Modified Davis grading — 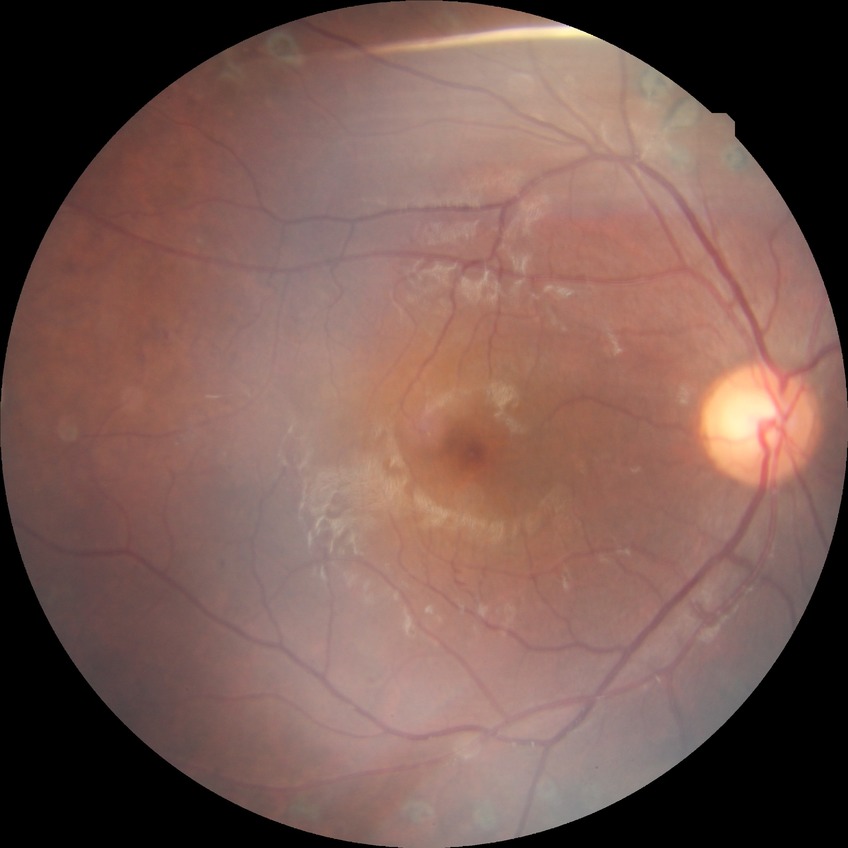
diabetic retinopathy (DR): proliferative diabetic retinopathy (PDR).